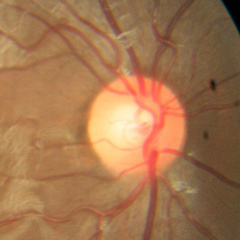
Demonstrates no glaucoma.